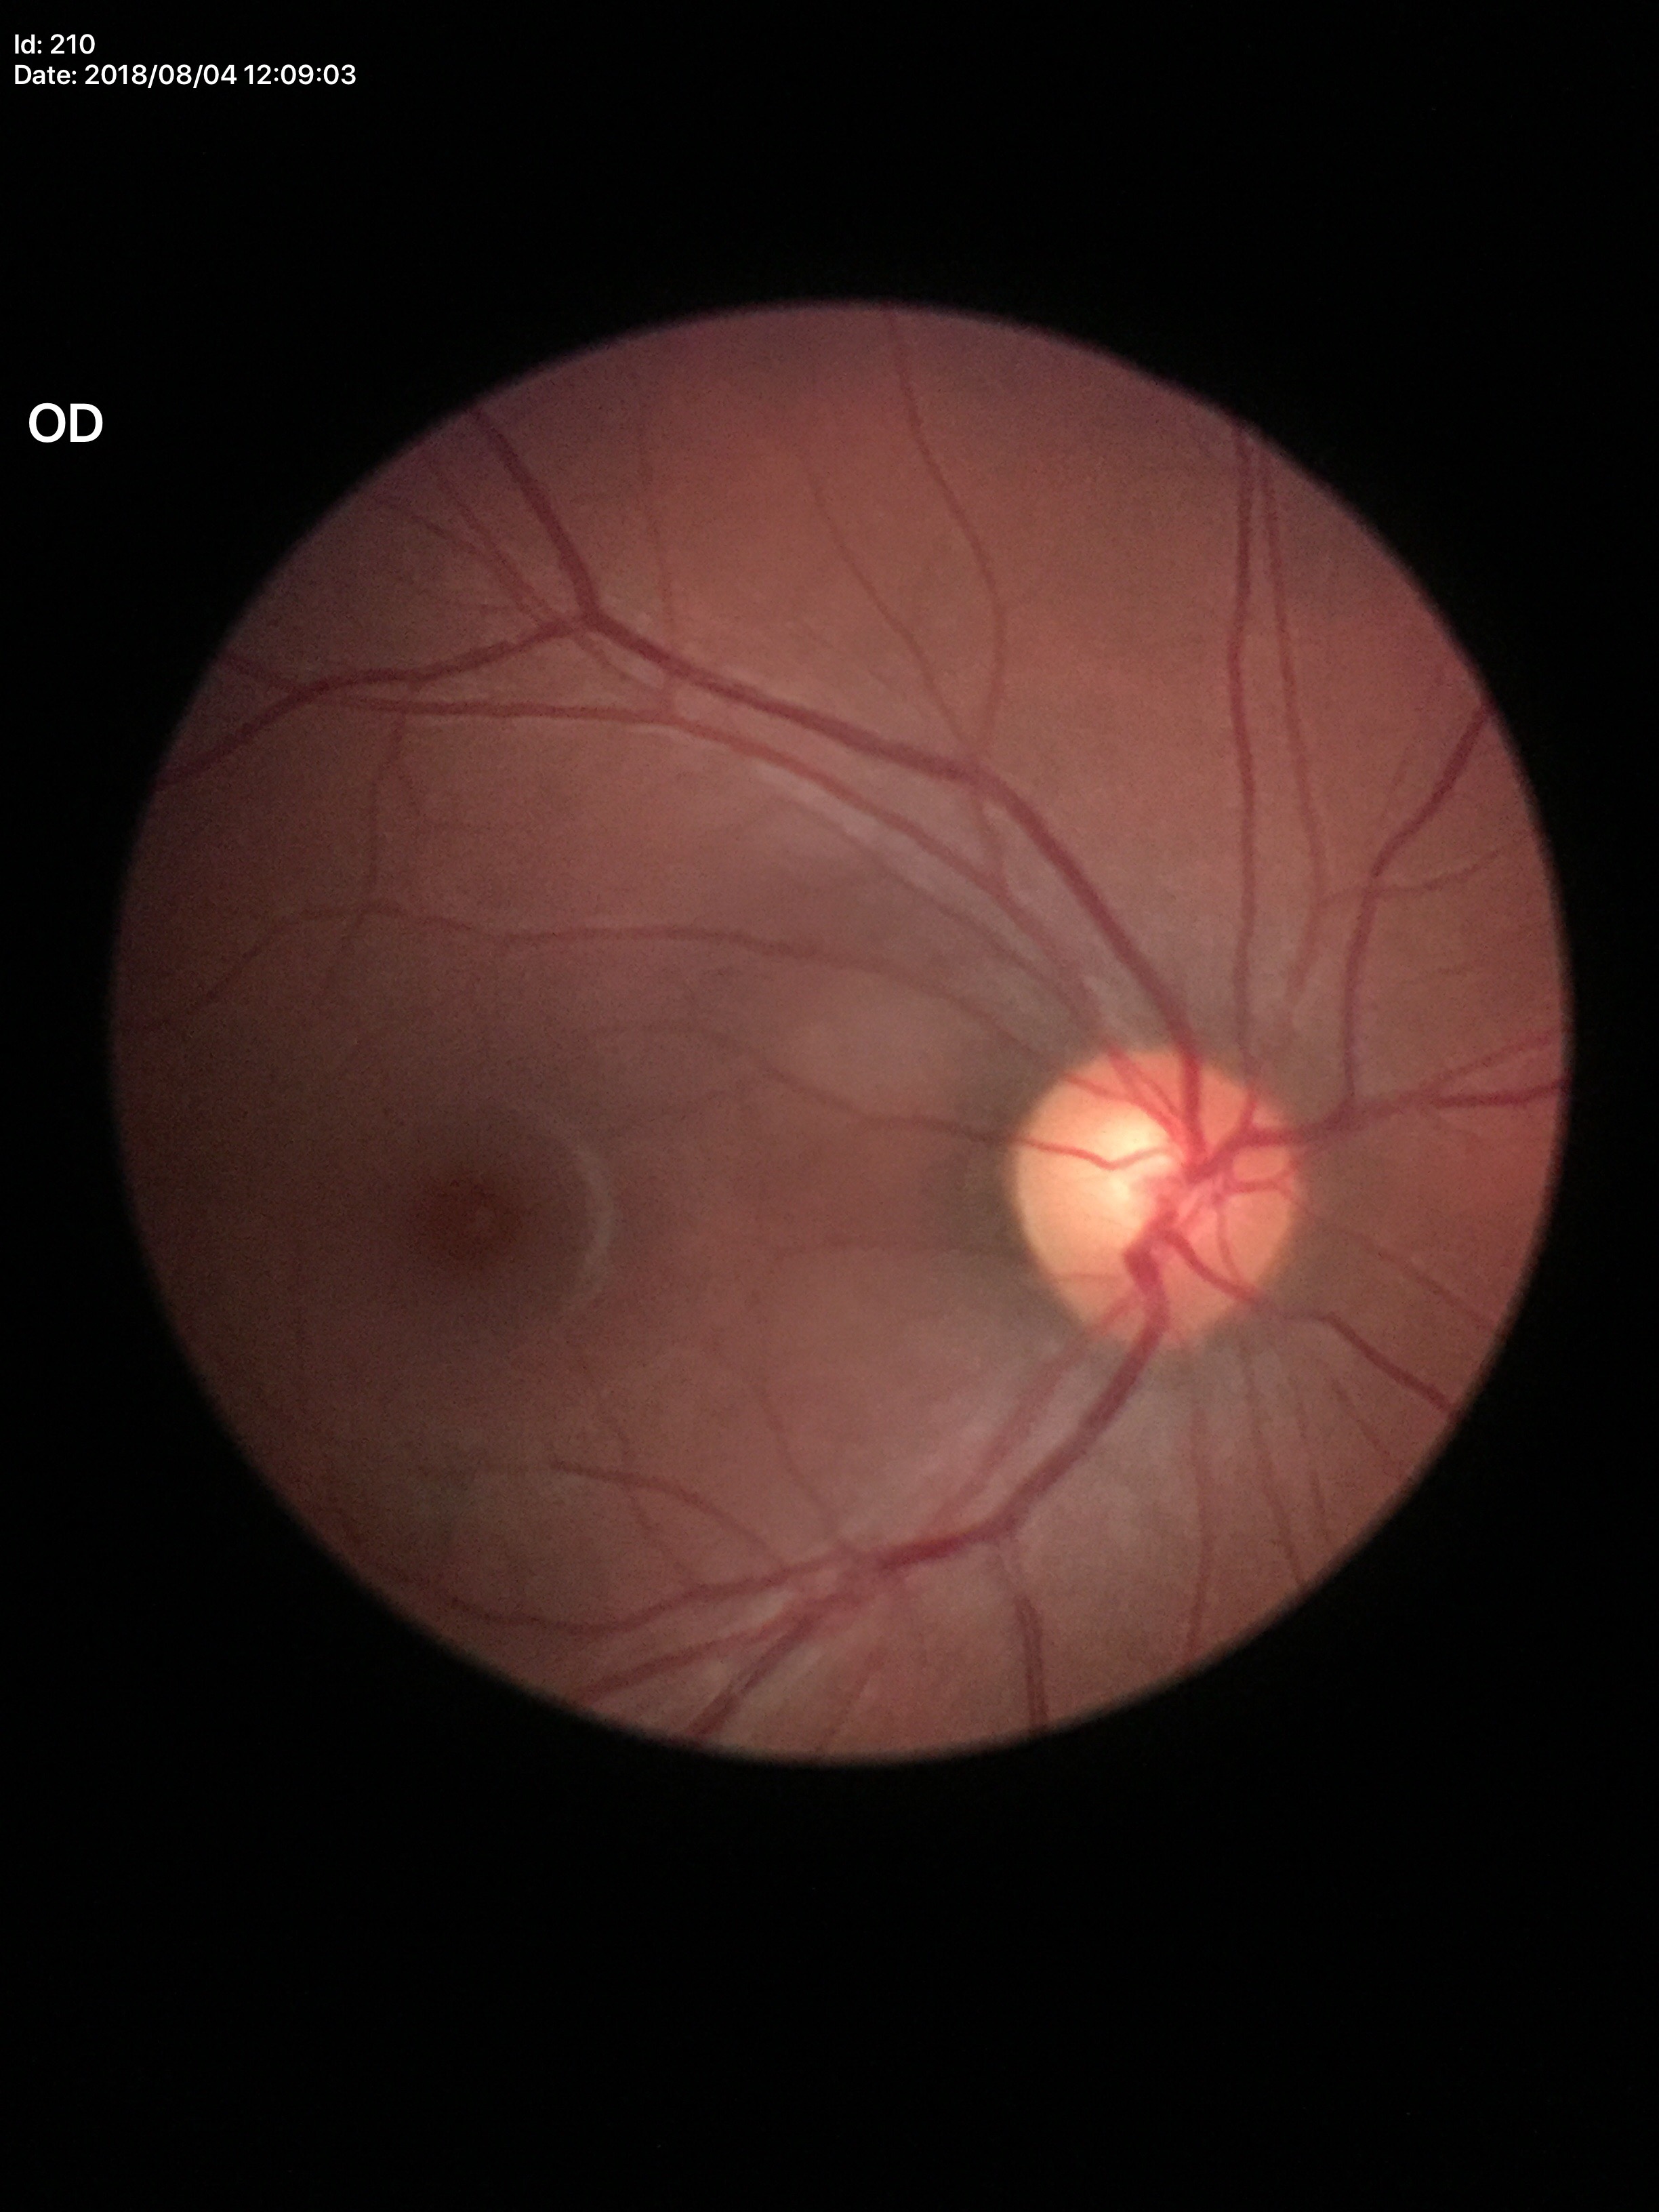
* Glaucoma assessment · negative
* VCDR · 0.56